Pediatric retinal photograph (wide-field). Image size 1440x1080 — 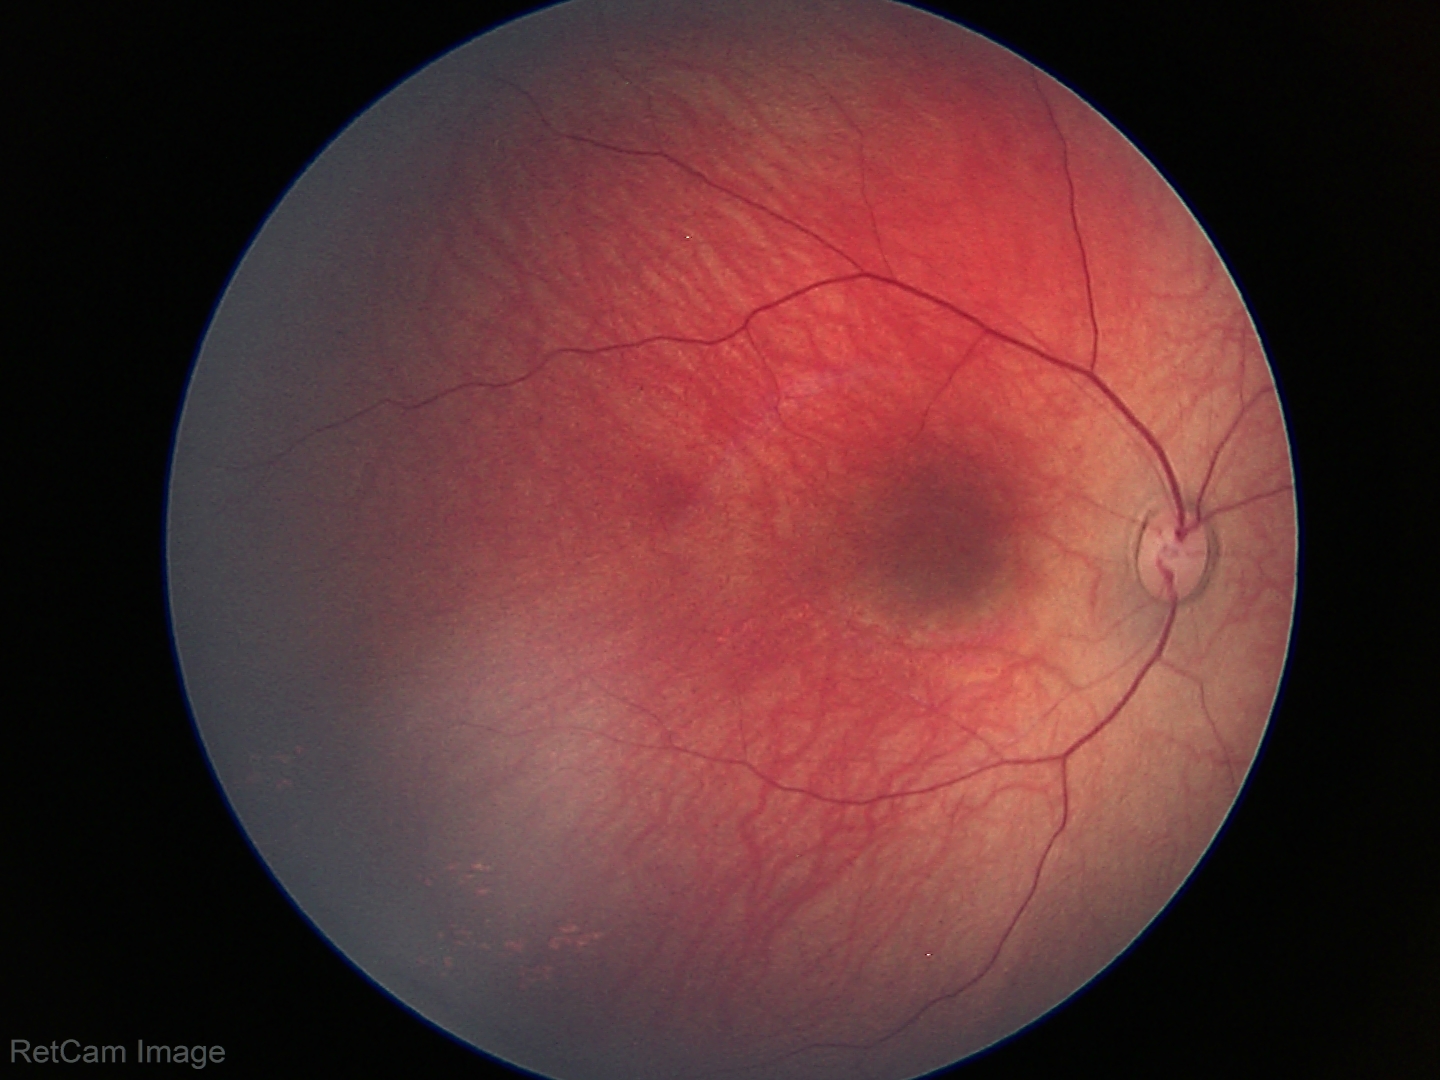 Normal screening examination.